Graded on the modified Davis scale — 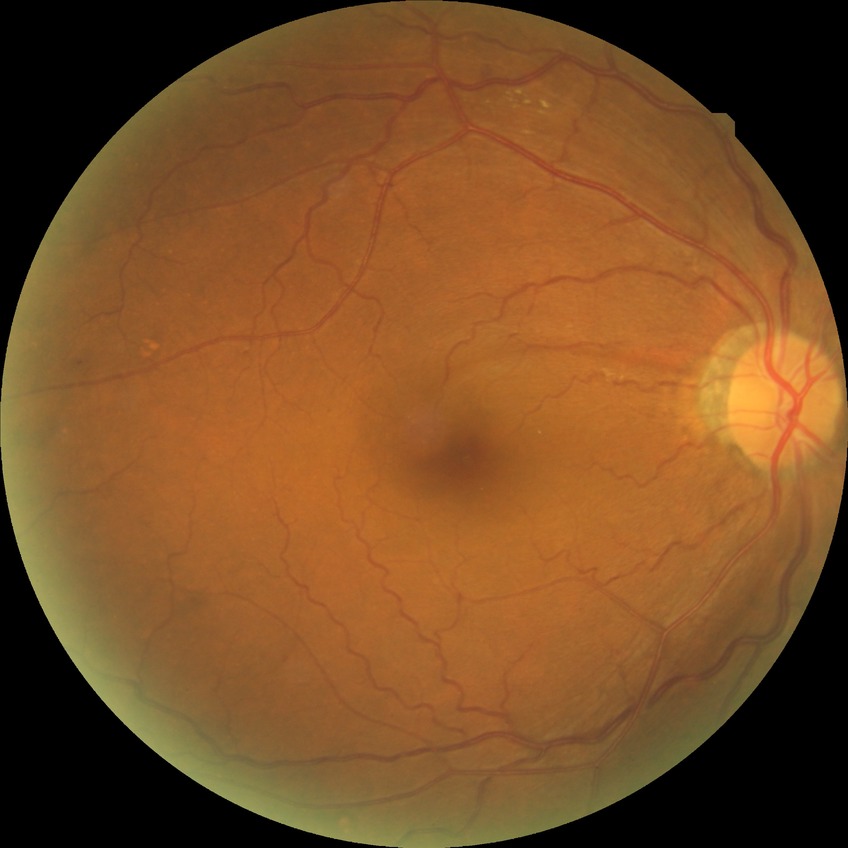
DR class = non-proliferative diabetic retinopathy, diabetic retinopathy (DR) = simple diabetic retinopathy (SDR).